Image size 640x480 · pediatric retinal photograph (wide-field).
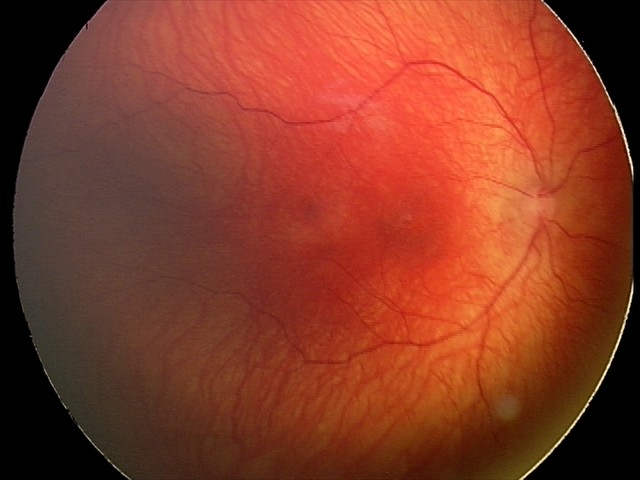 Screening examination consistent with status post retinopathy of prematurity (ROP).